Wide-field fundus image from infant ROP screening: 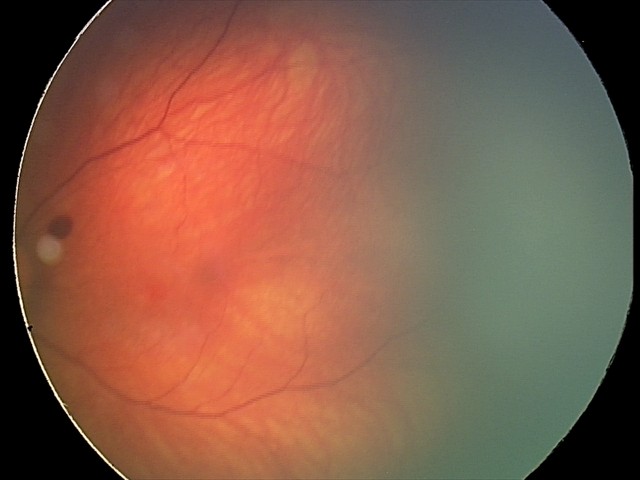

Assessment = retinal hemorrhages